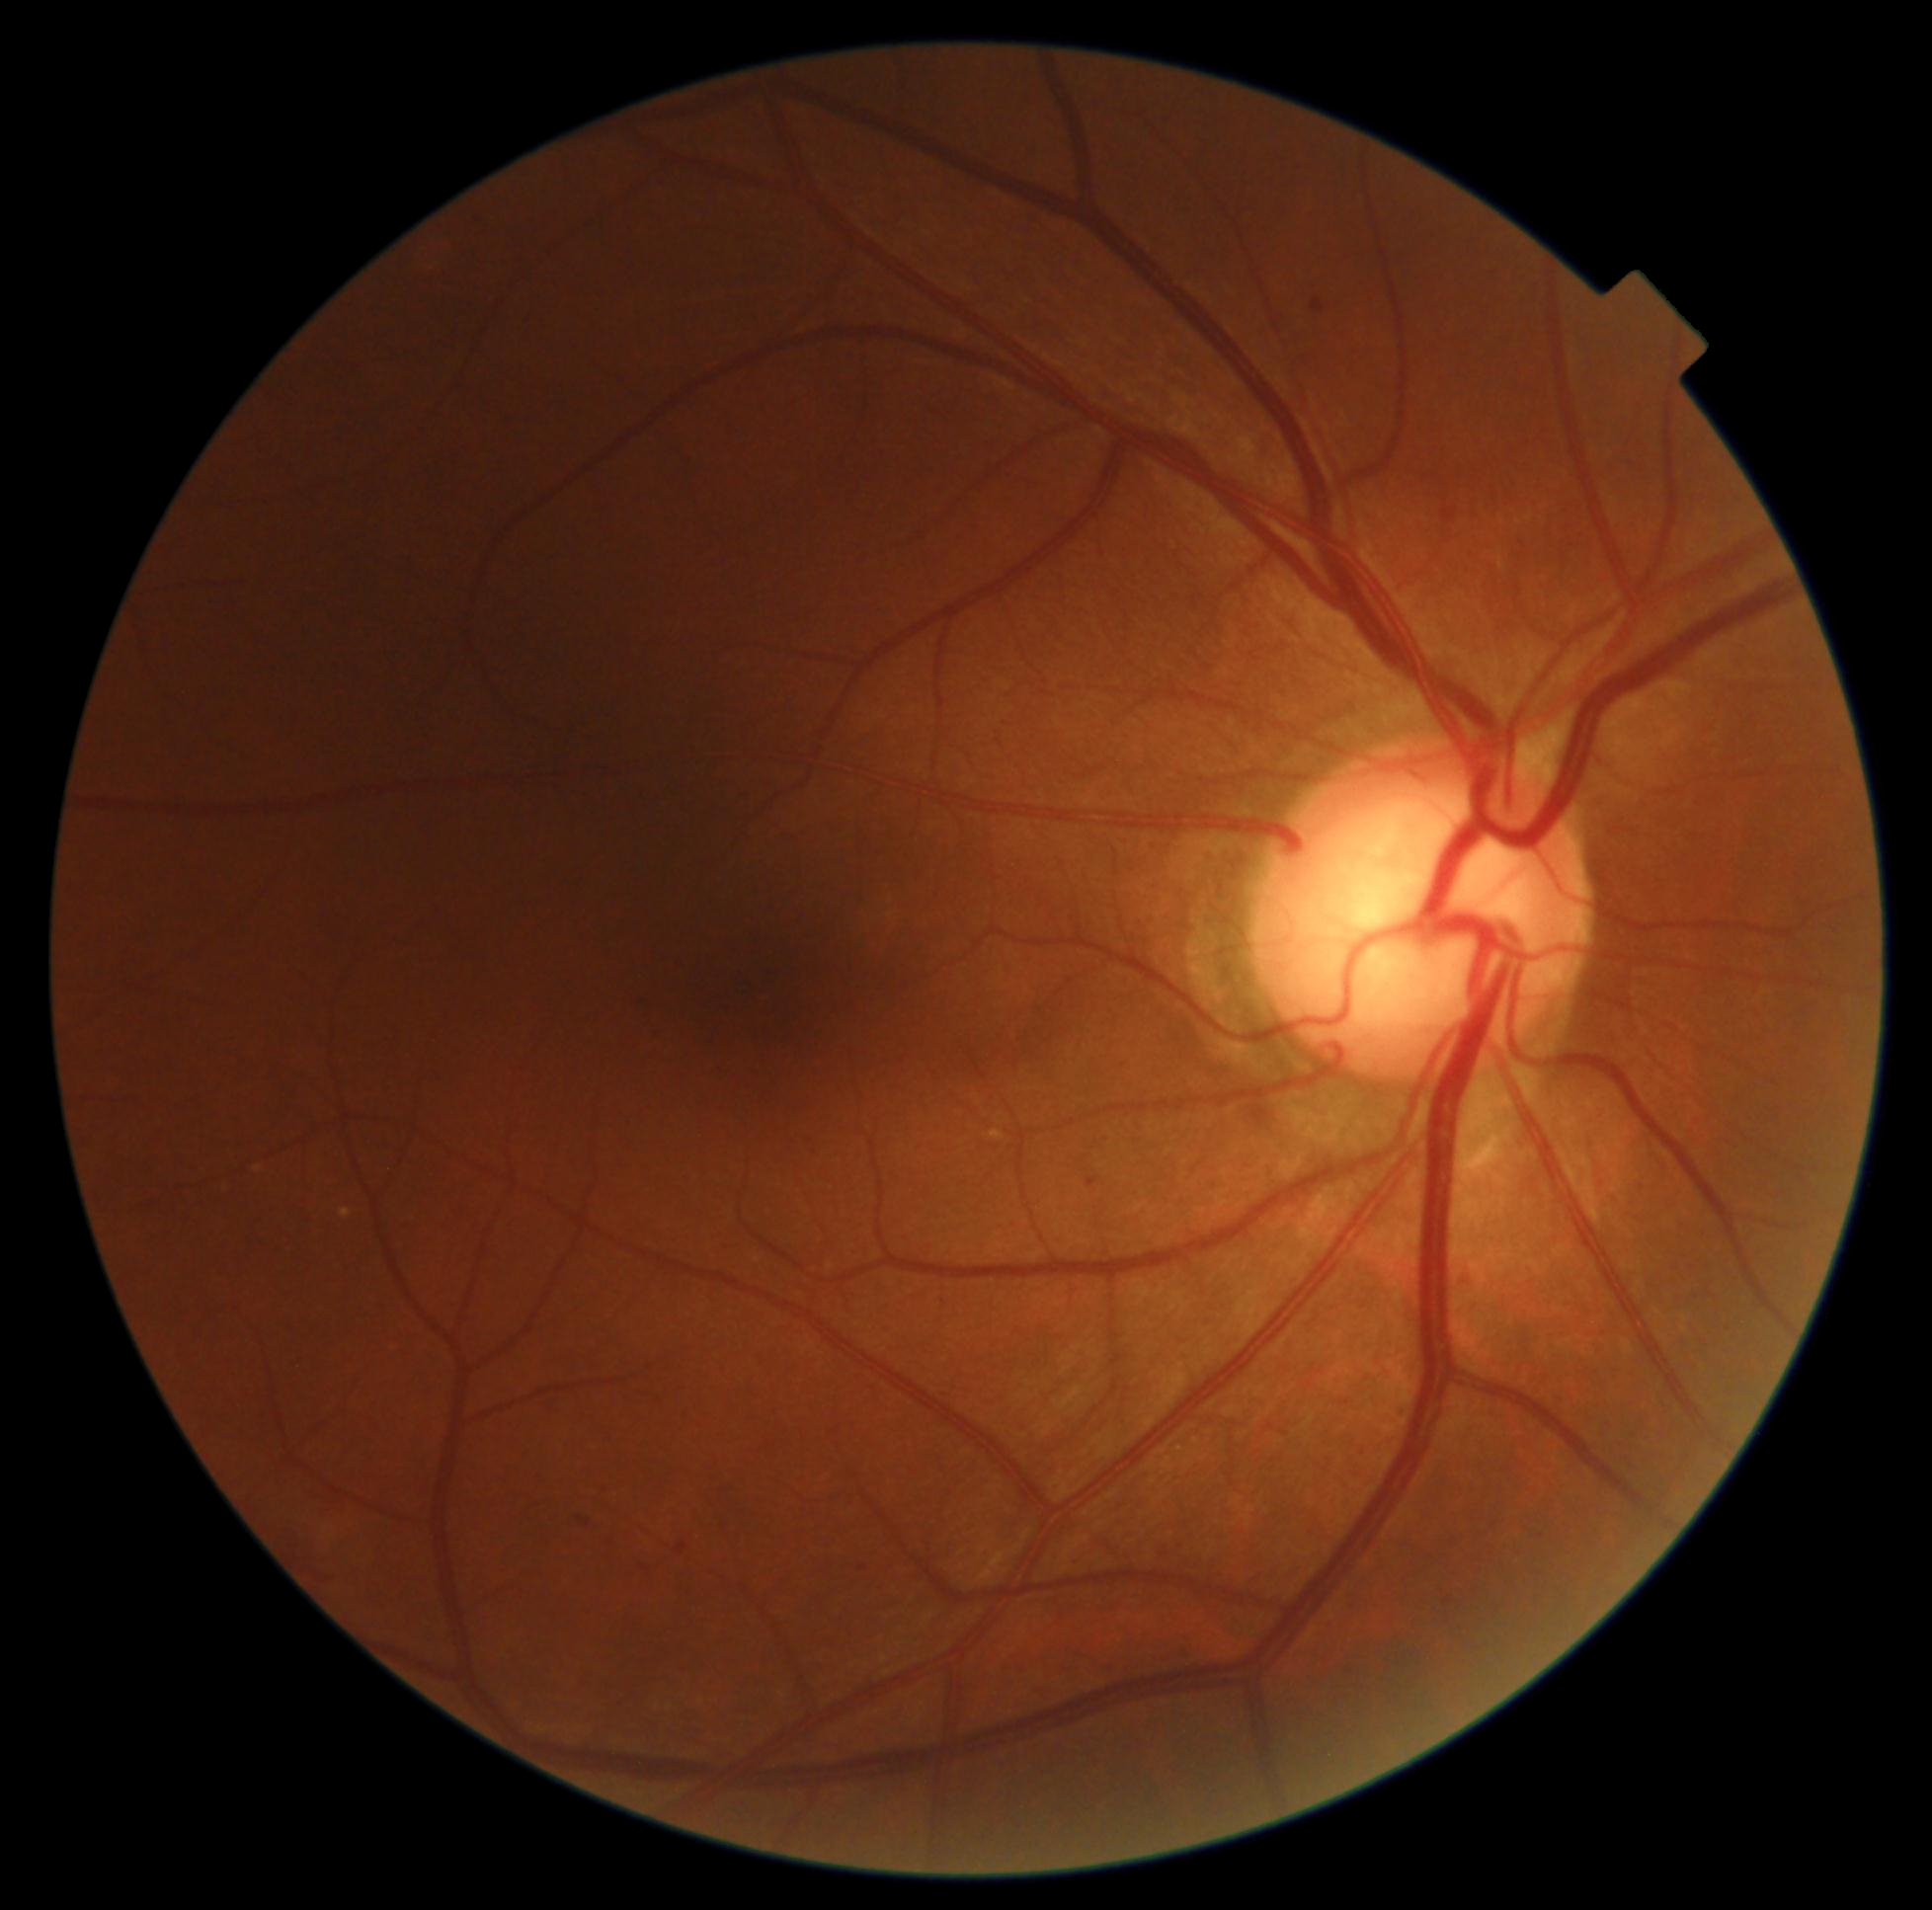
DR severity=1.